Modified Davis classification — 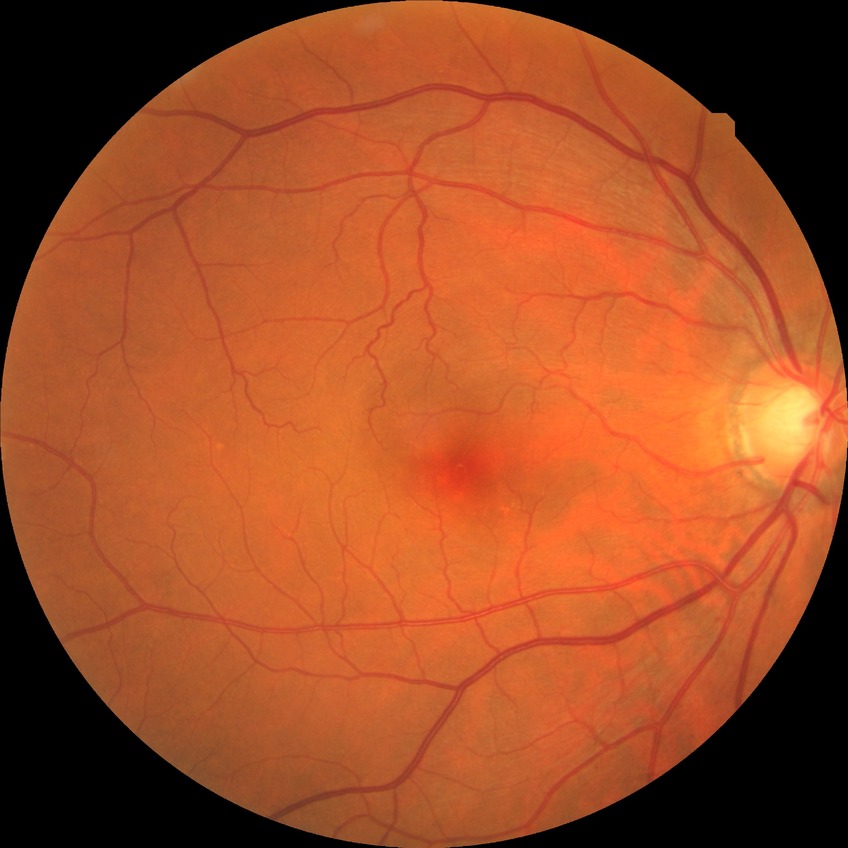 Davis grading: no diabetic retinopathy.